Color fundus photograph: 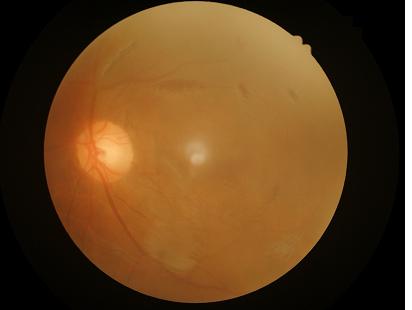 Sharpness = reduced sharpness with visible blur; Overall = poor and difficult to use diagnostically; Illumination/color = uneven illumination or color cast; Contrast = low, vessels and details hard to distinguish.